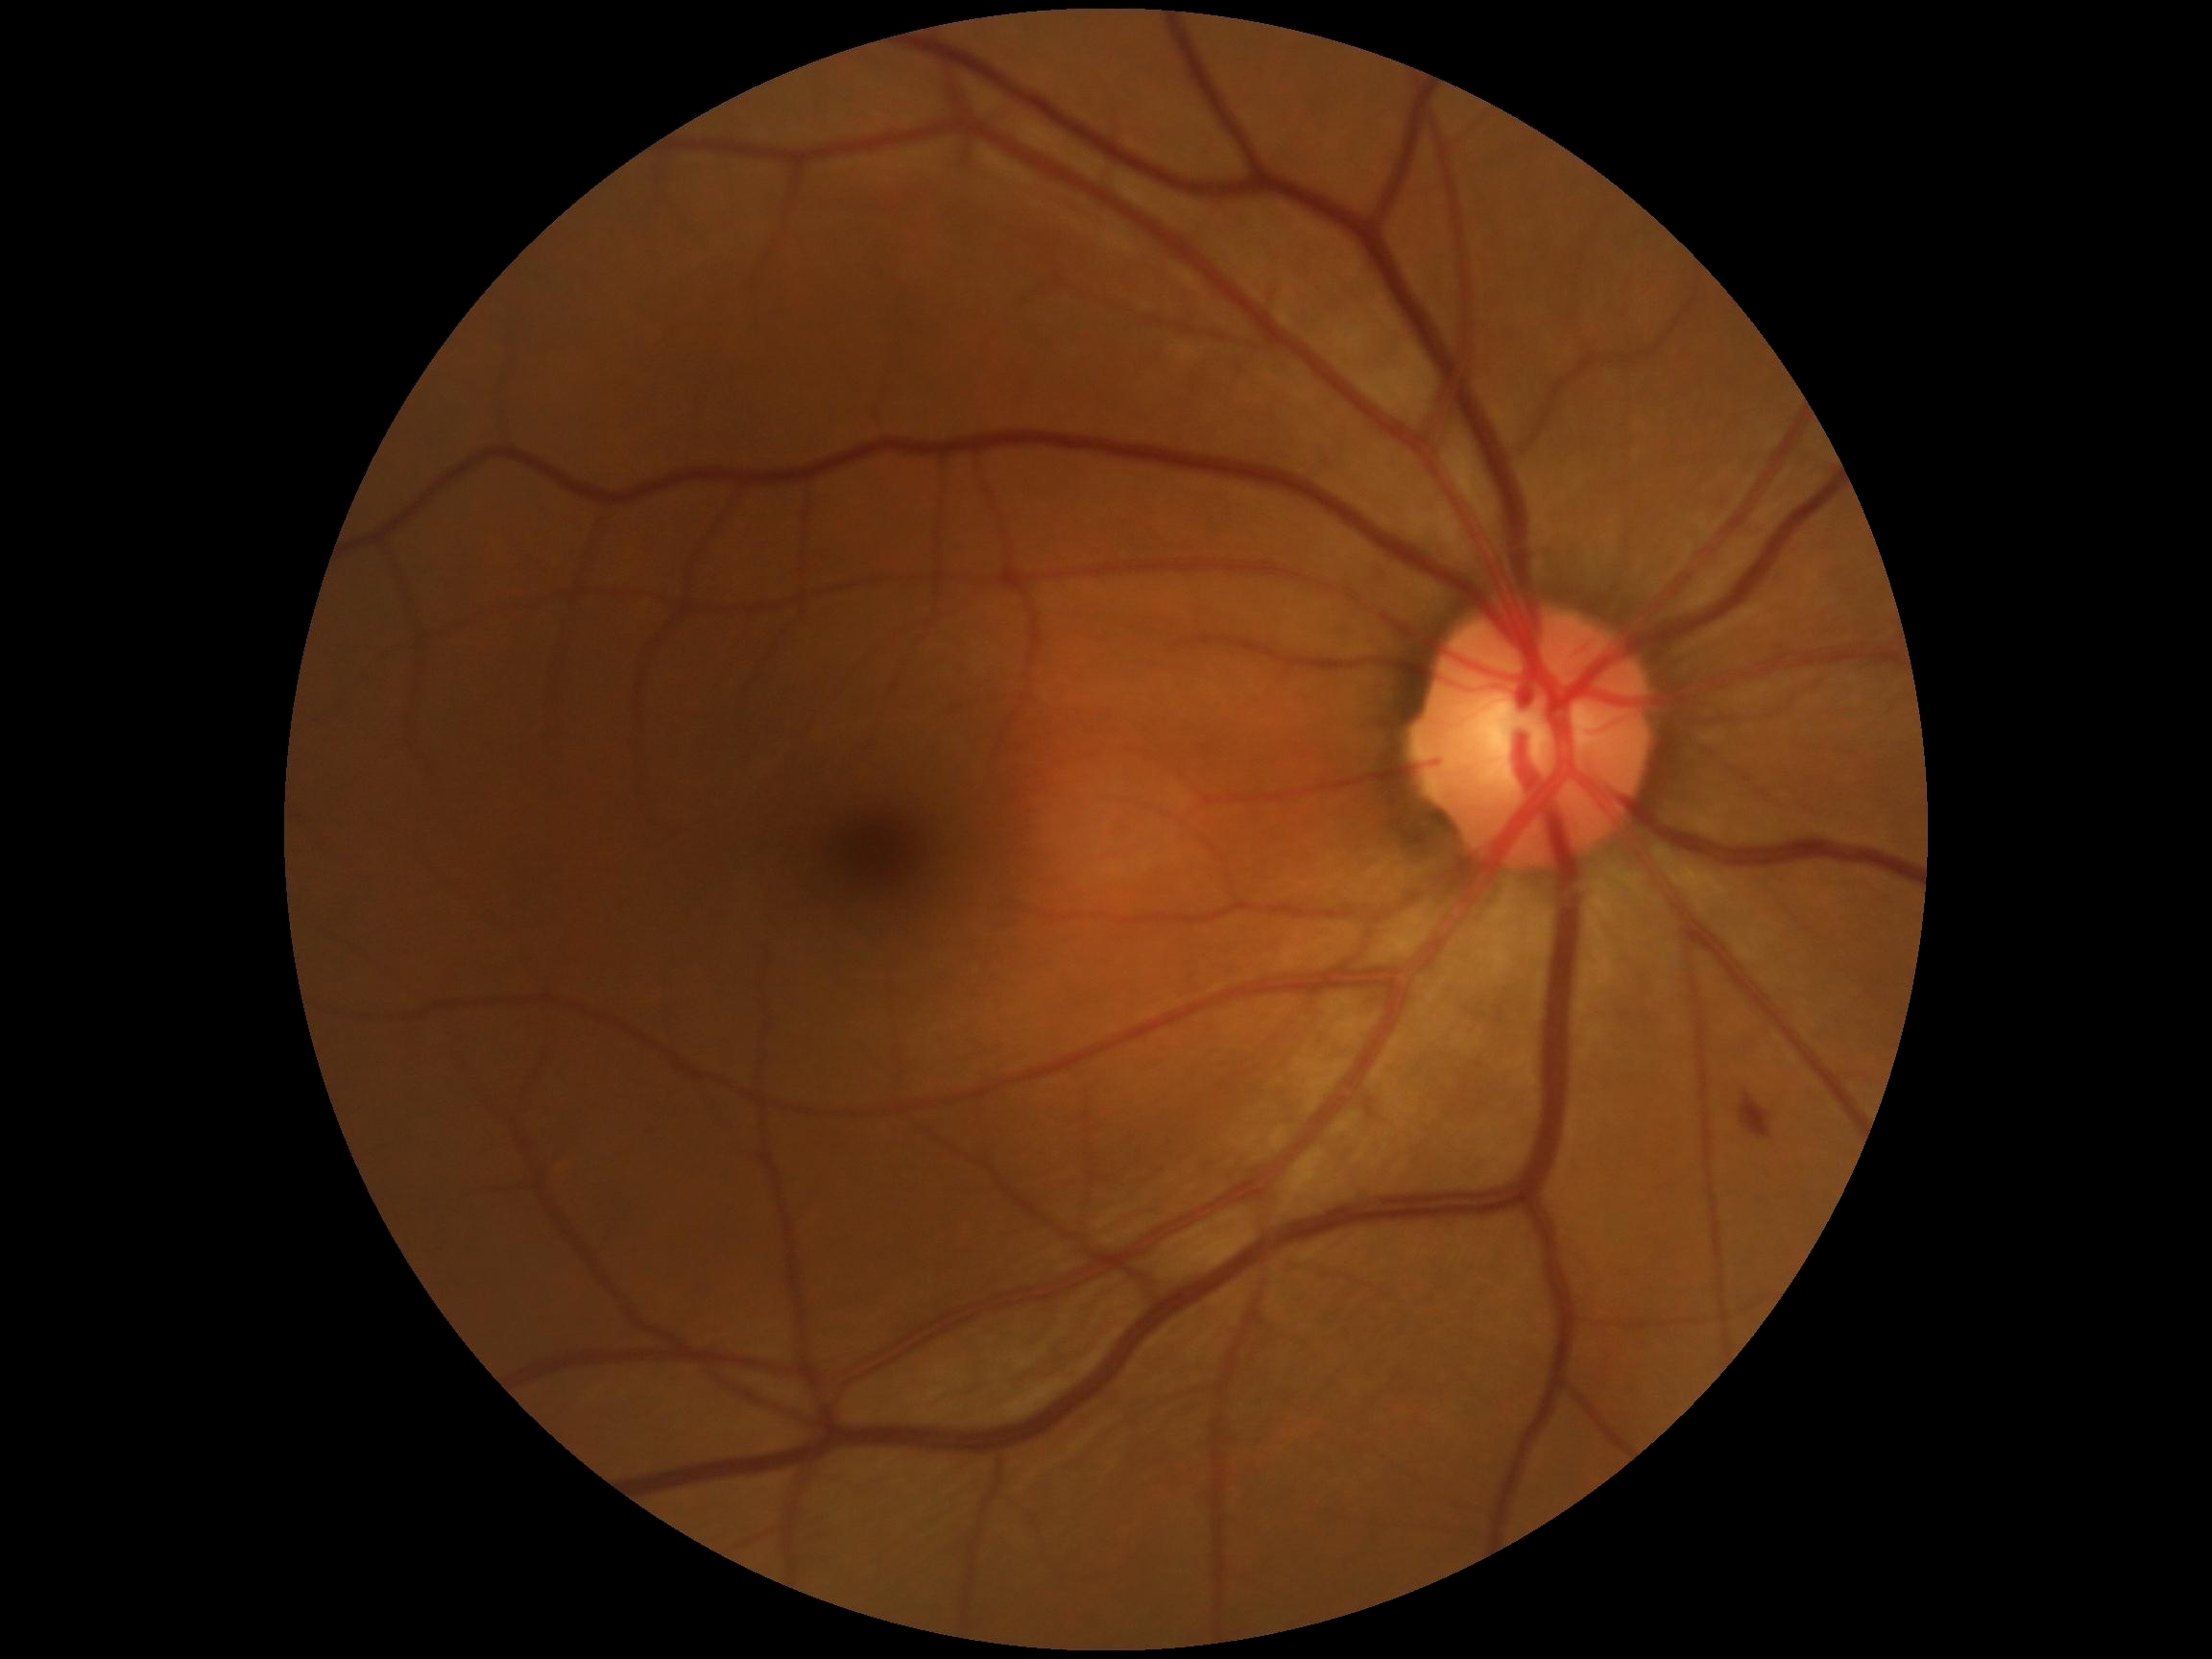
DR severity: grade 2 (moderate NPDR).